Color fundus photograph; image size 2048x1536; 45° FOV.
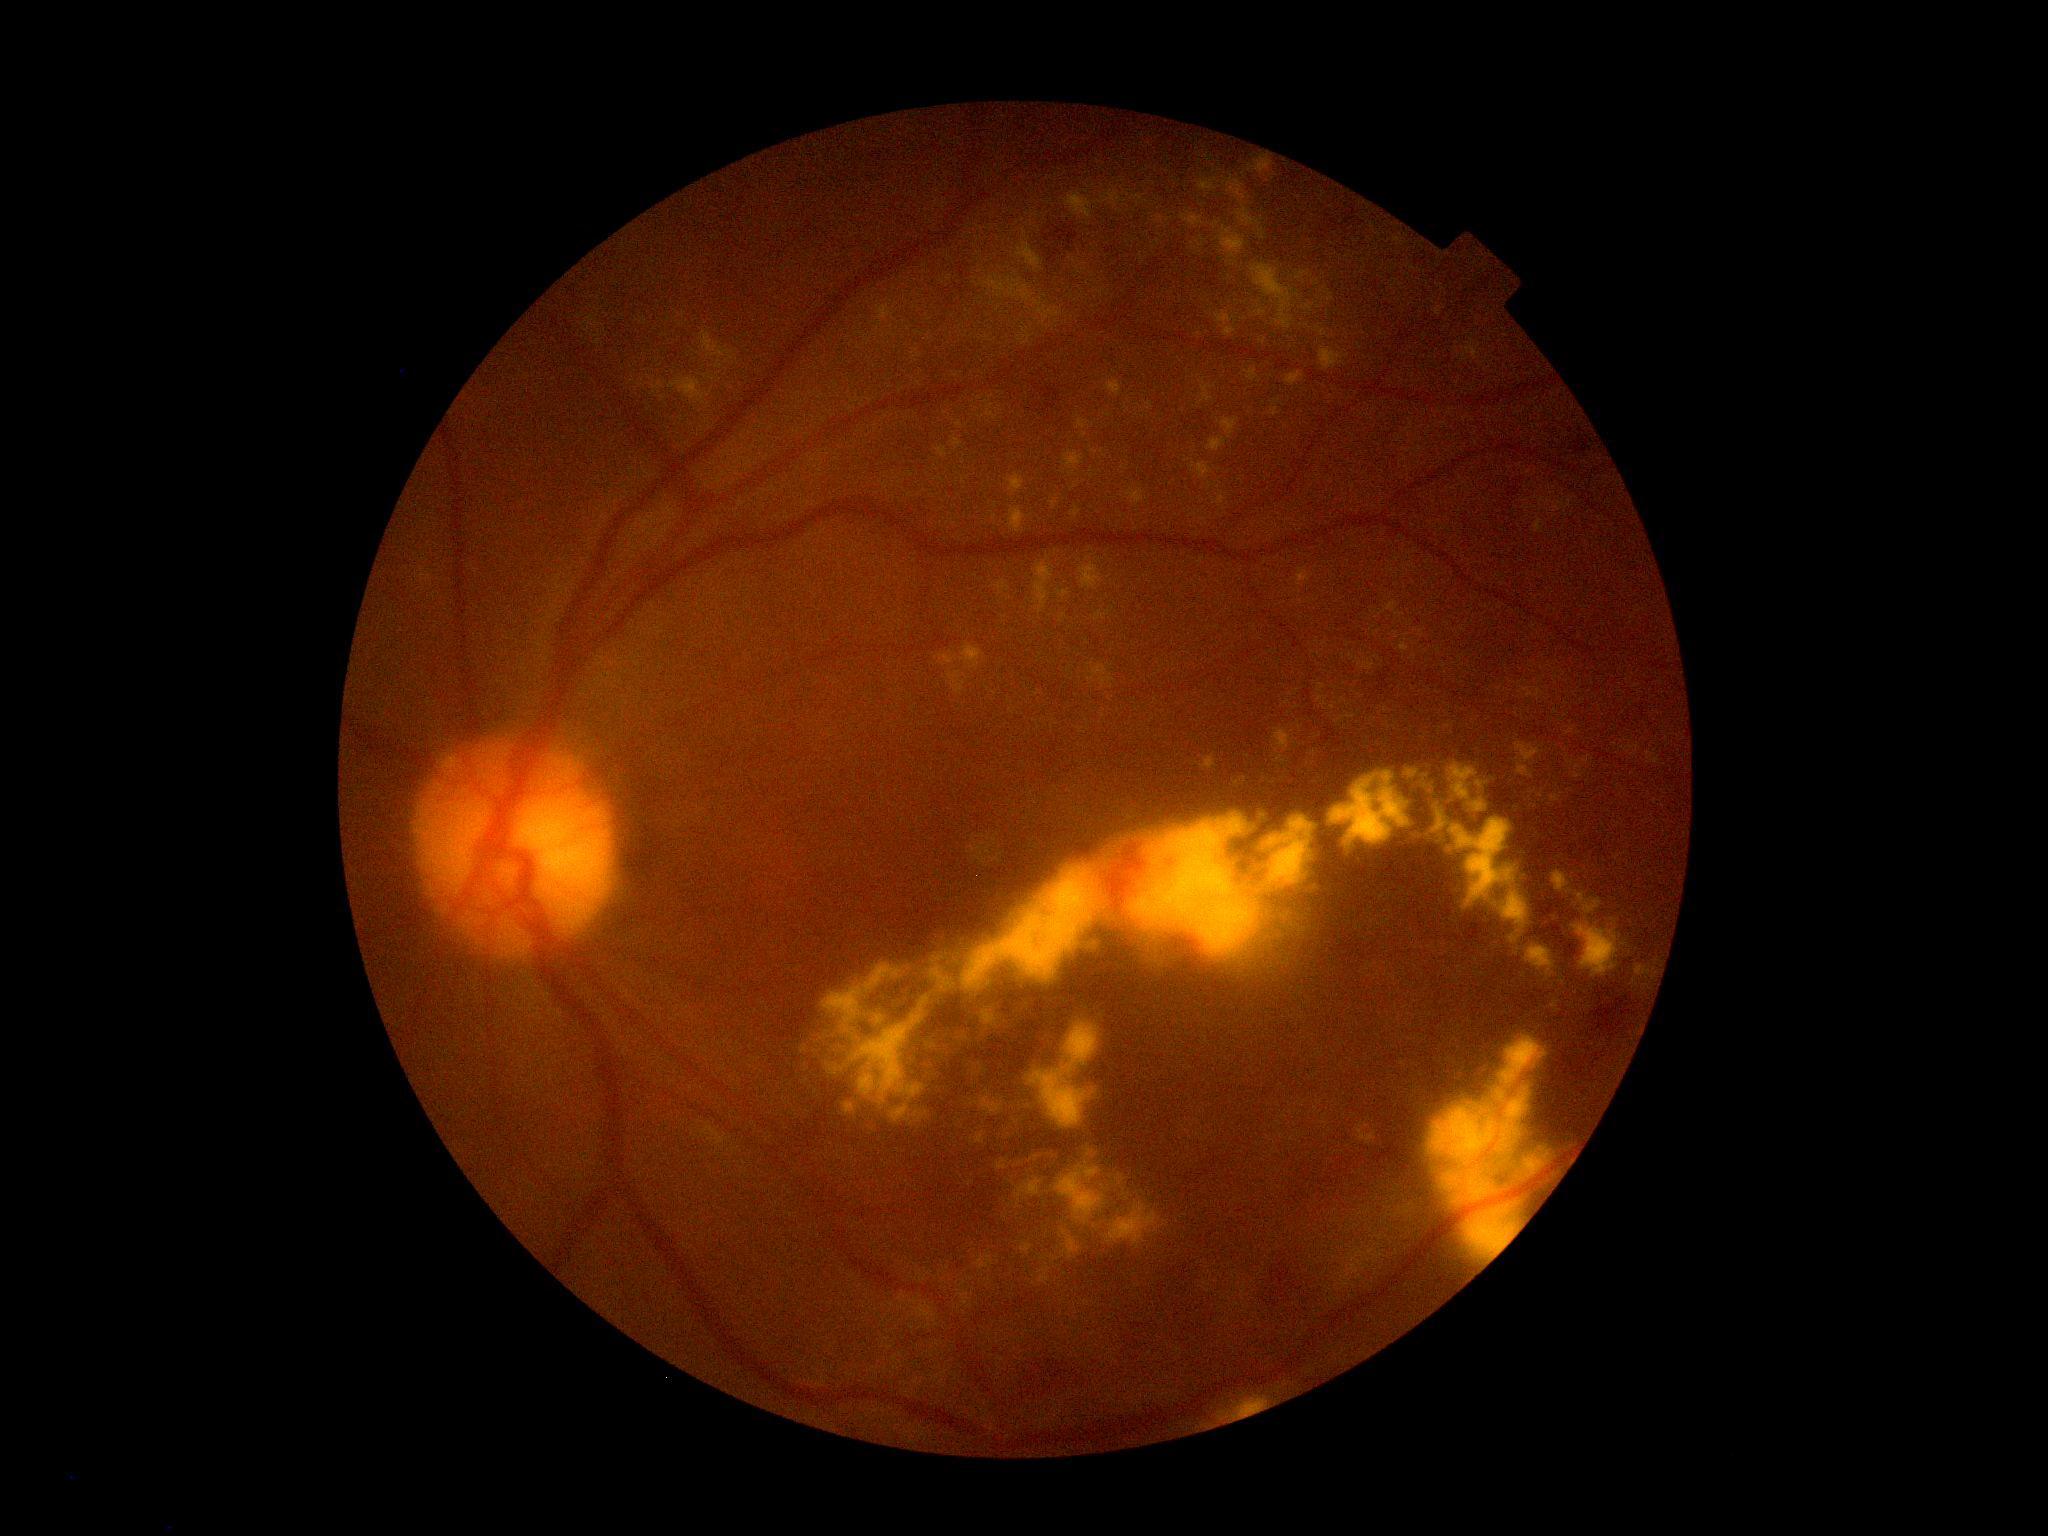

DR class=non-proliferative diabetic retinopathy; diabetic retinopathy severity=2.